45° field of view. Camera: NIDEK AFC-230. Davis DR grading — 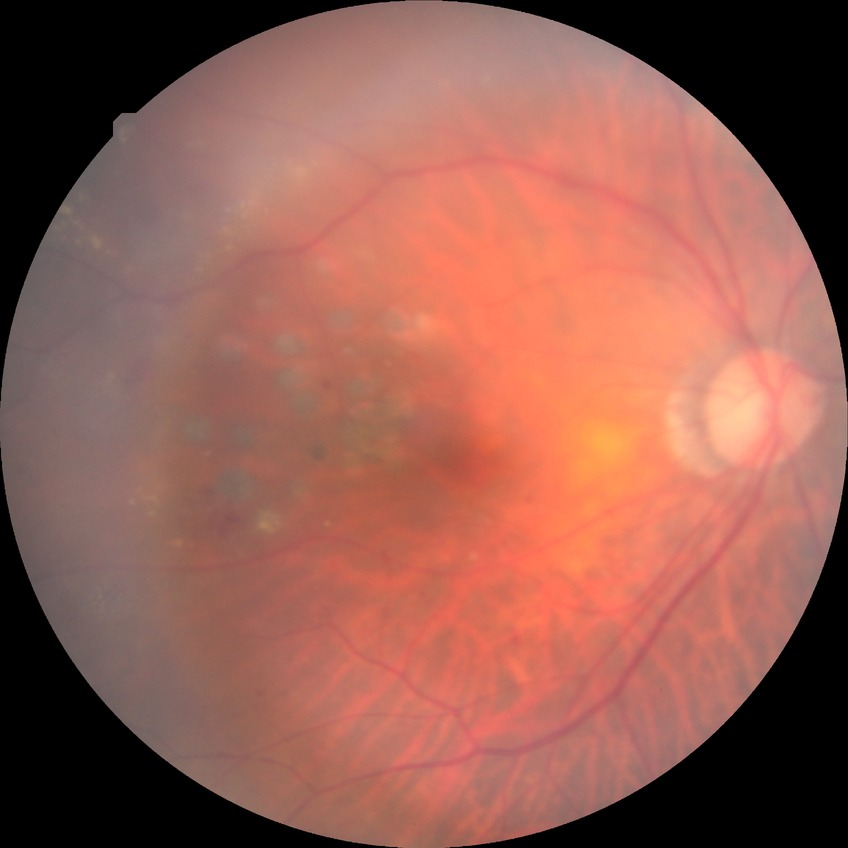
DR: PPDR.